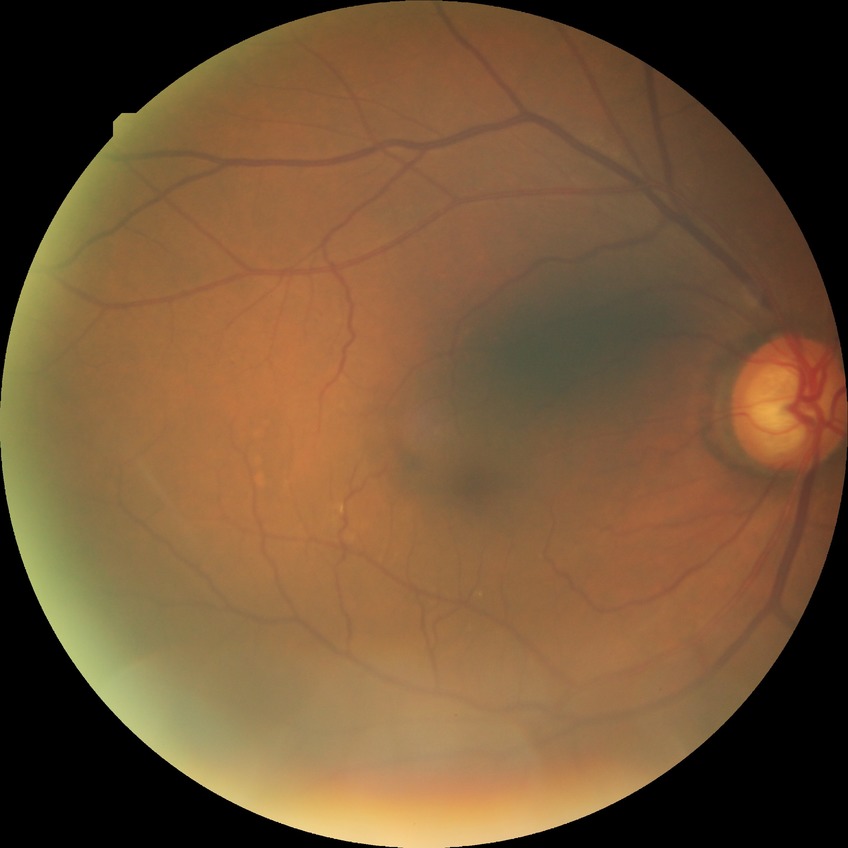

Diabetic retinopathy (DR): no diabetic retinopathy (NDR).